45-degree field of view
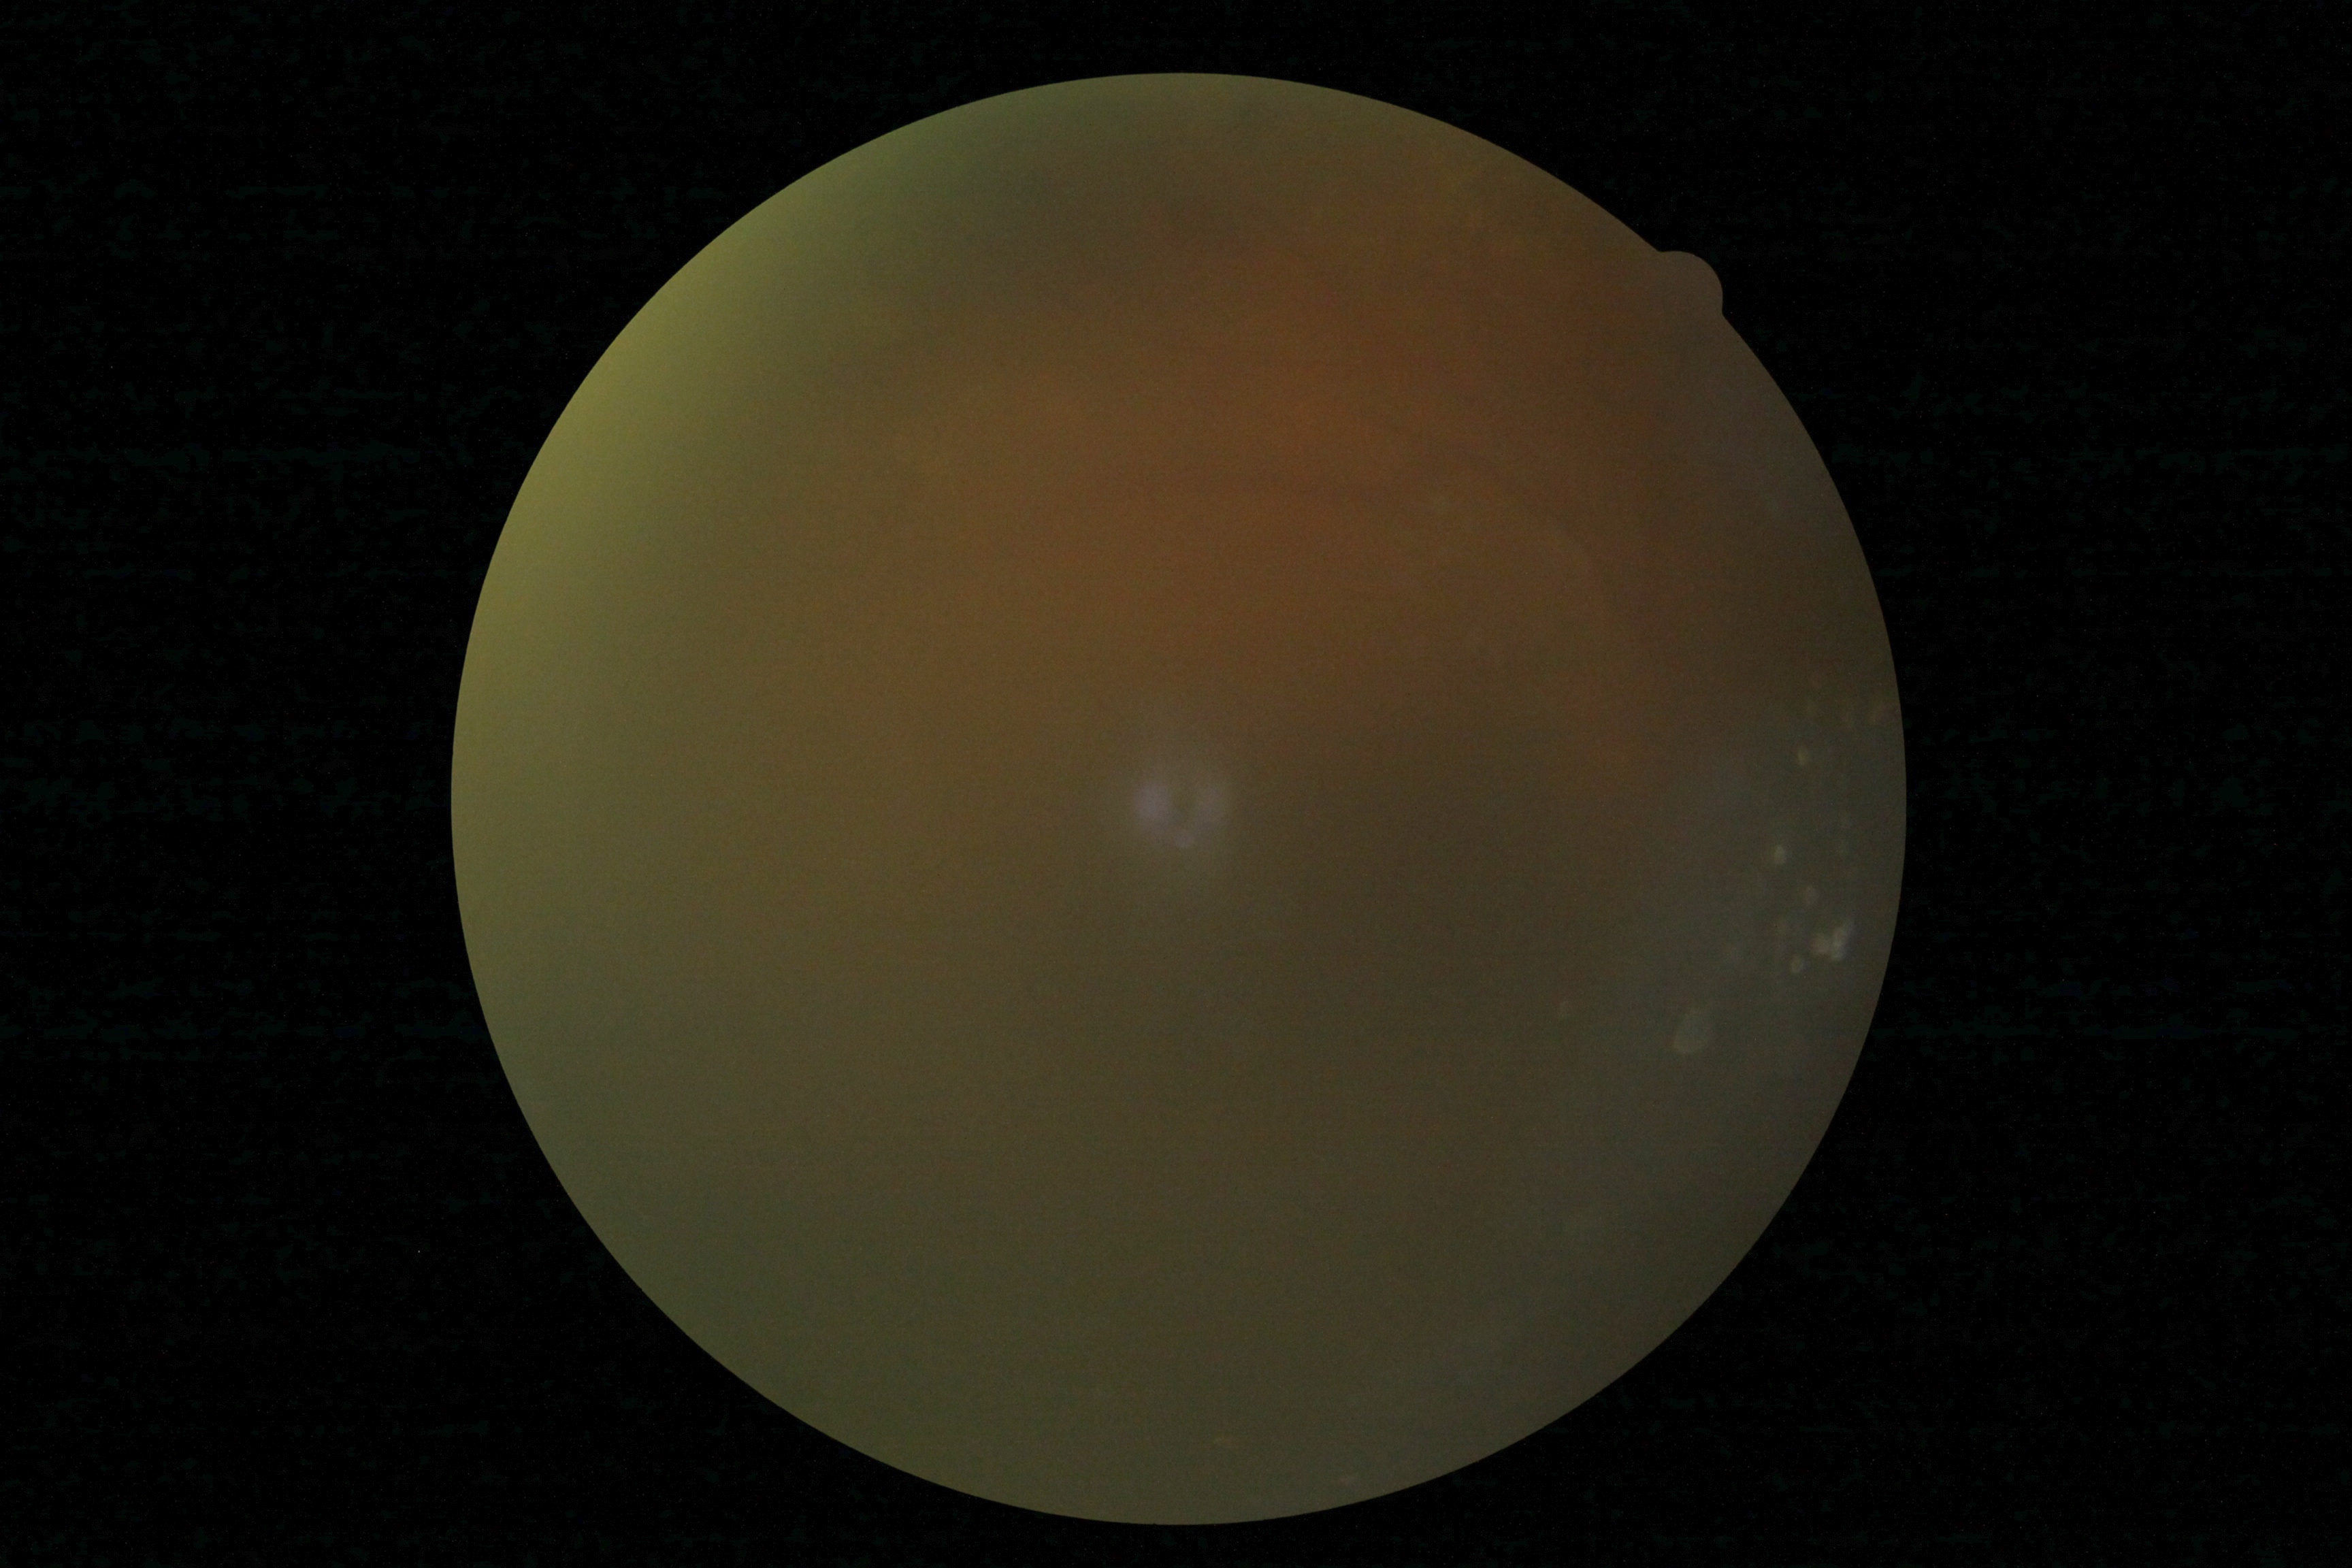 Diabetic retinopathy (DR) is ungradable due to poor image quality.